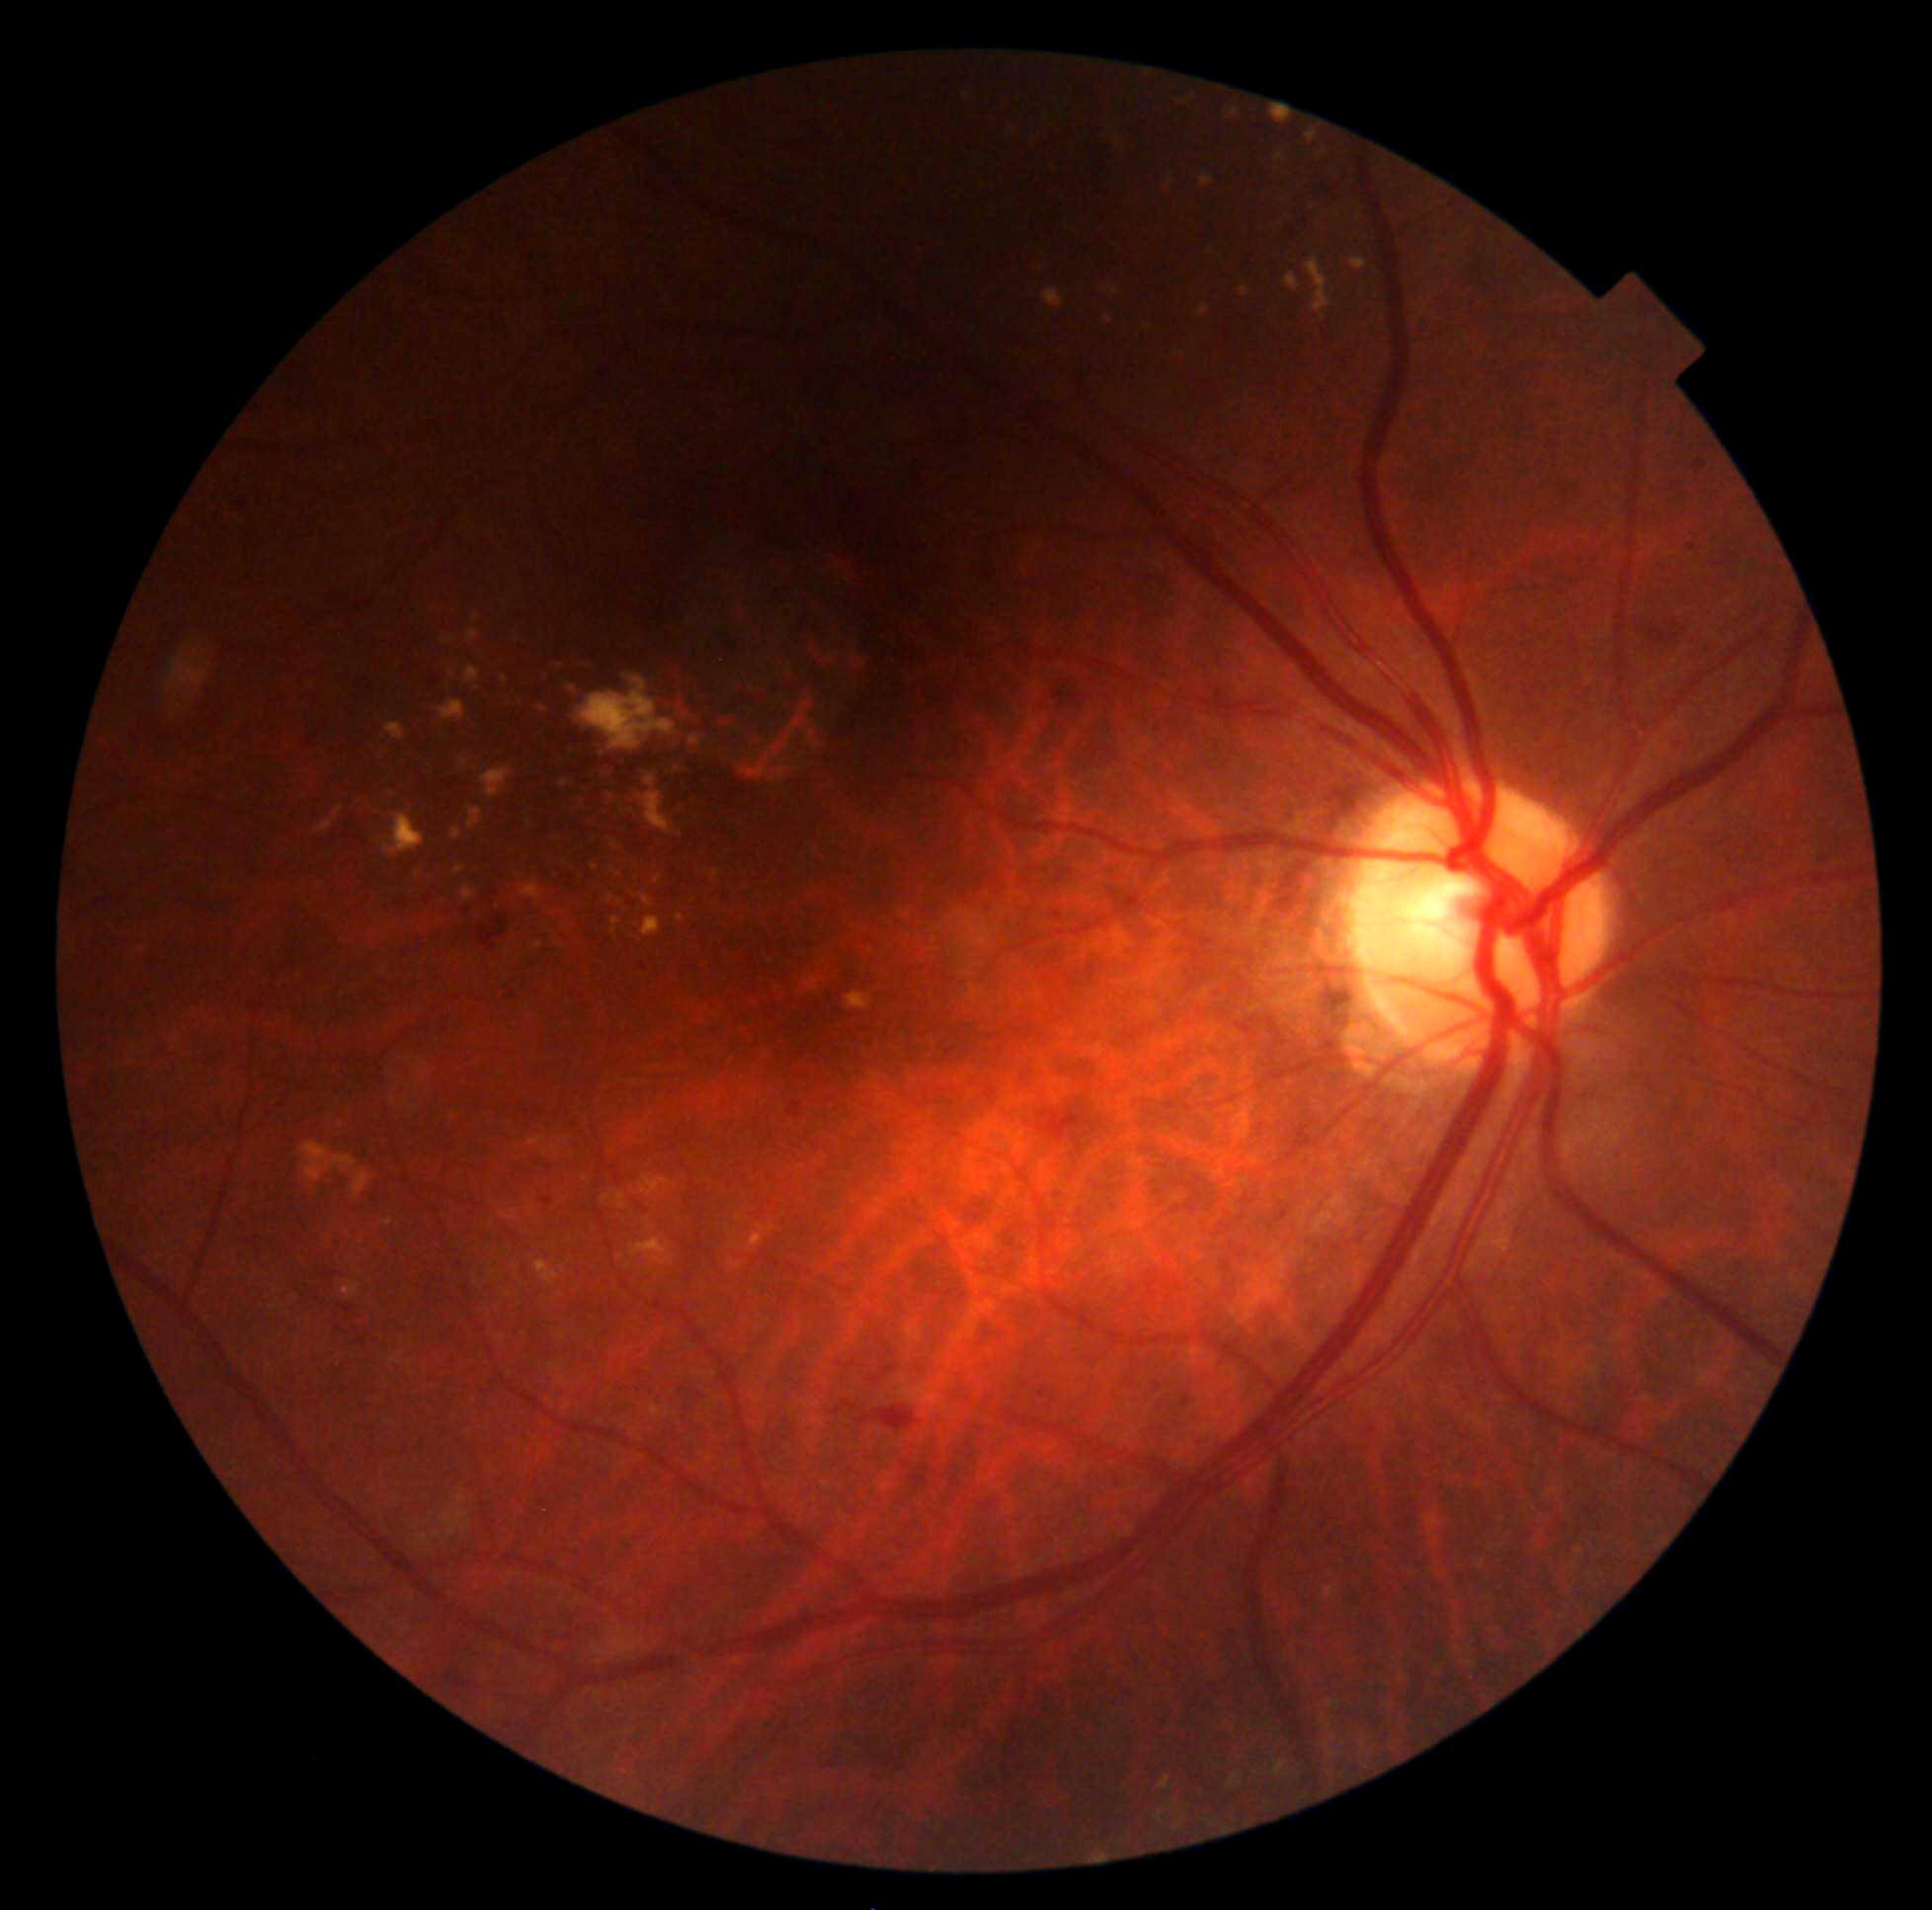 DR is grade 2 — more than just microaneurysms but less than severe NPDR
Lesions identified (partial list):
EXs (subset) = 464/668/480/687 | 1104/317/1112/325 | 468/631/480/642 | 645/1220/654/1233 | 712/872/719/881 | 743/765/767/780 | 846/992/871/1010 | 455/866/466/875 | 774/752/787/764 | 383/814/425/859 | 482/769/513/798 | 381/1220/394/1227 | 750/1225/776/1248 | 1350/257/1367/271
Additional small EXs near (x=418, y=875) | (x=564, y=949) | (x=610, y=900) | (x=443, y=642) | (x=505, y=679) | (x=495, y=966)